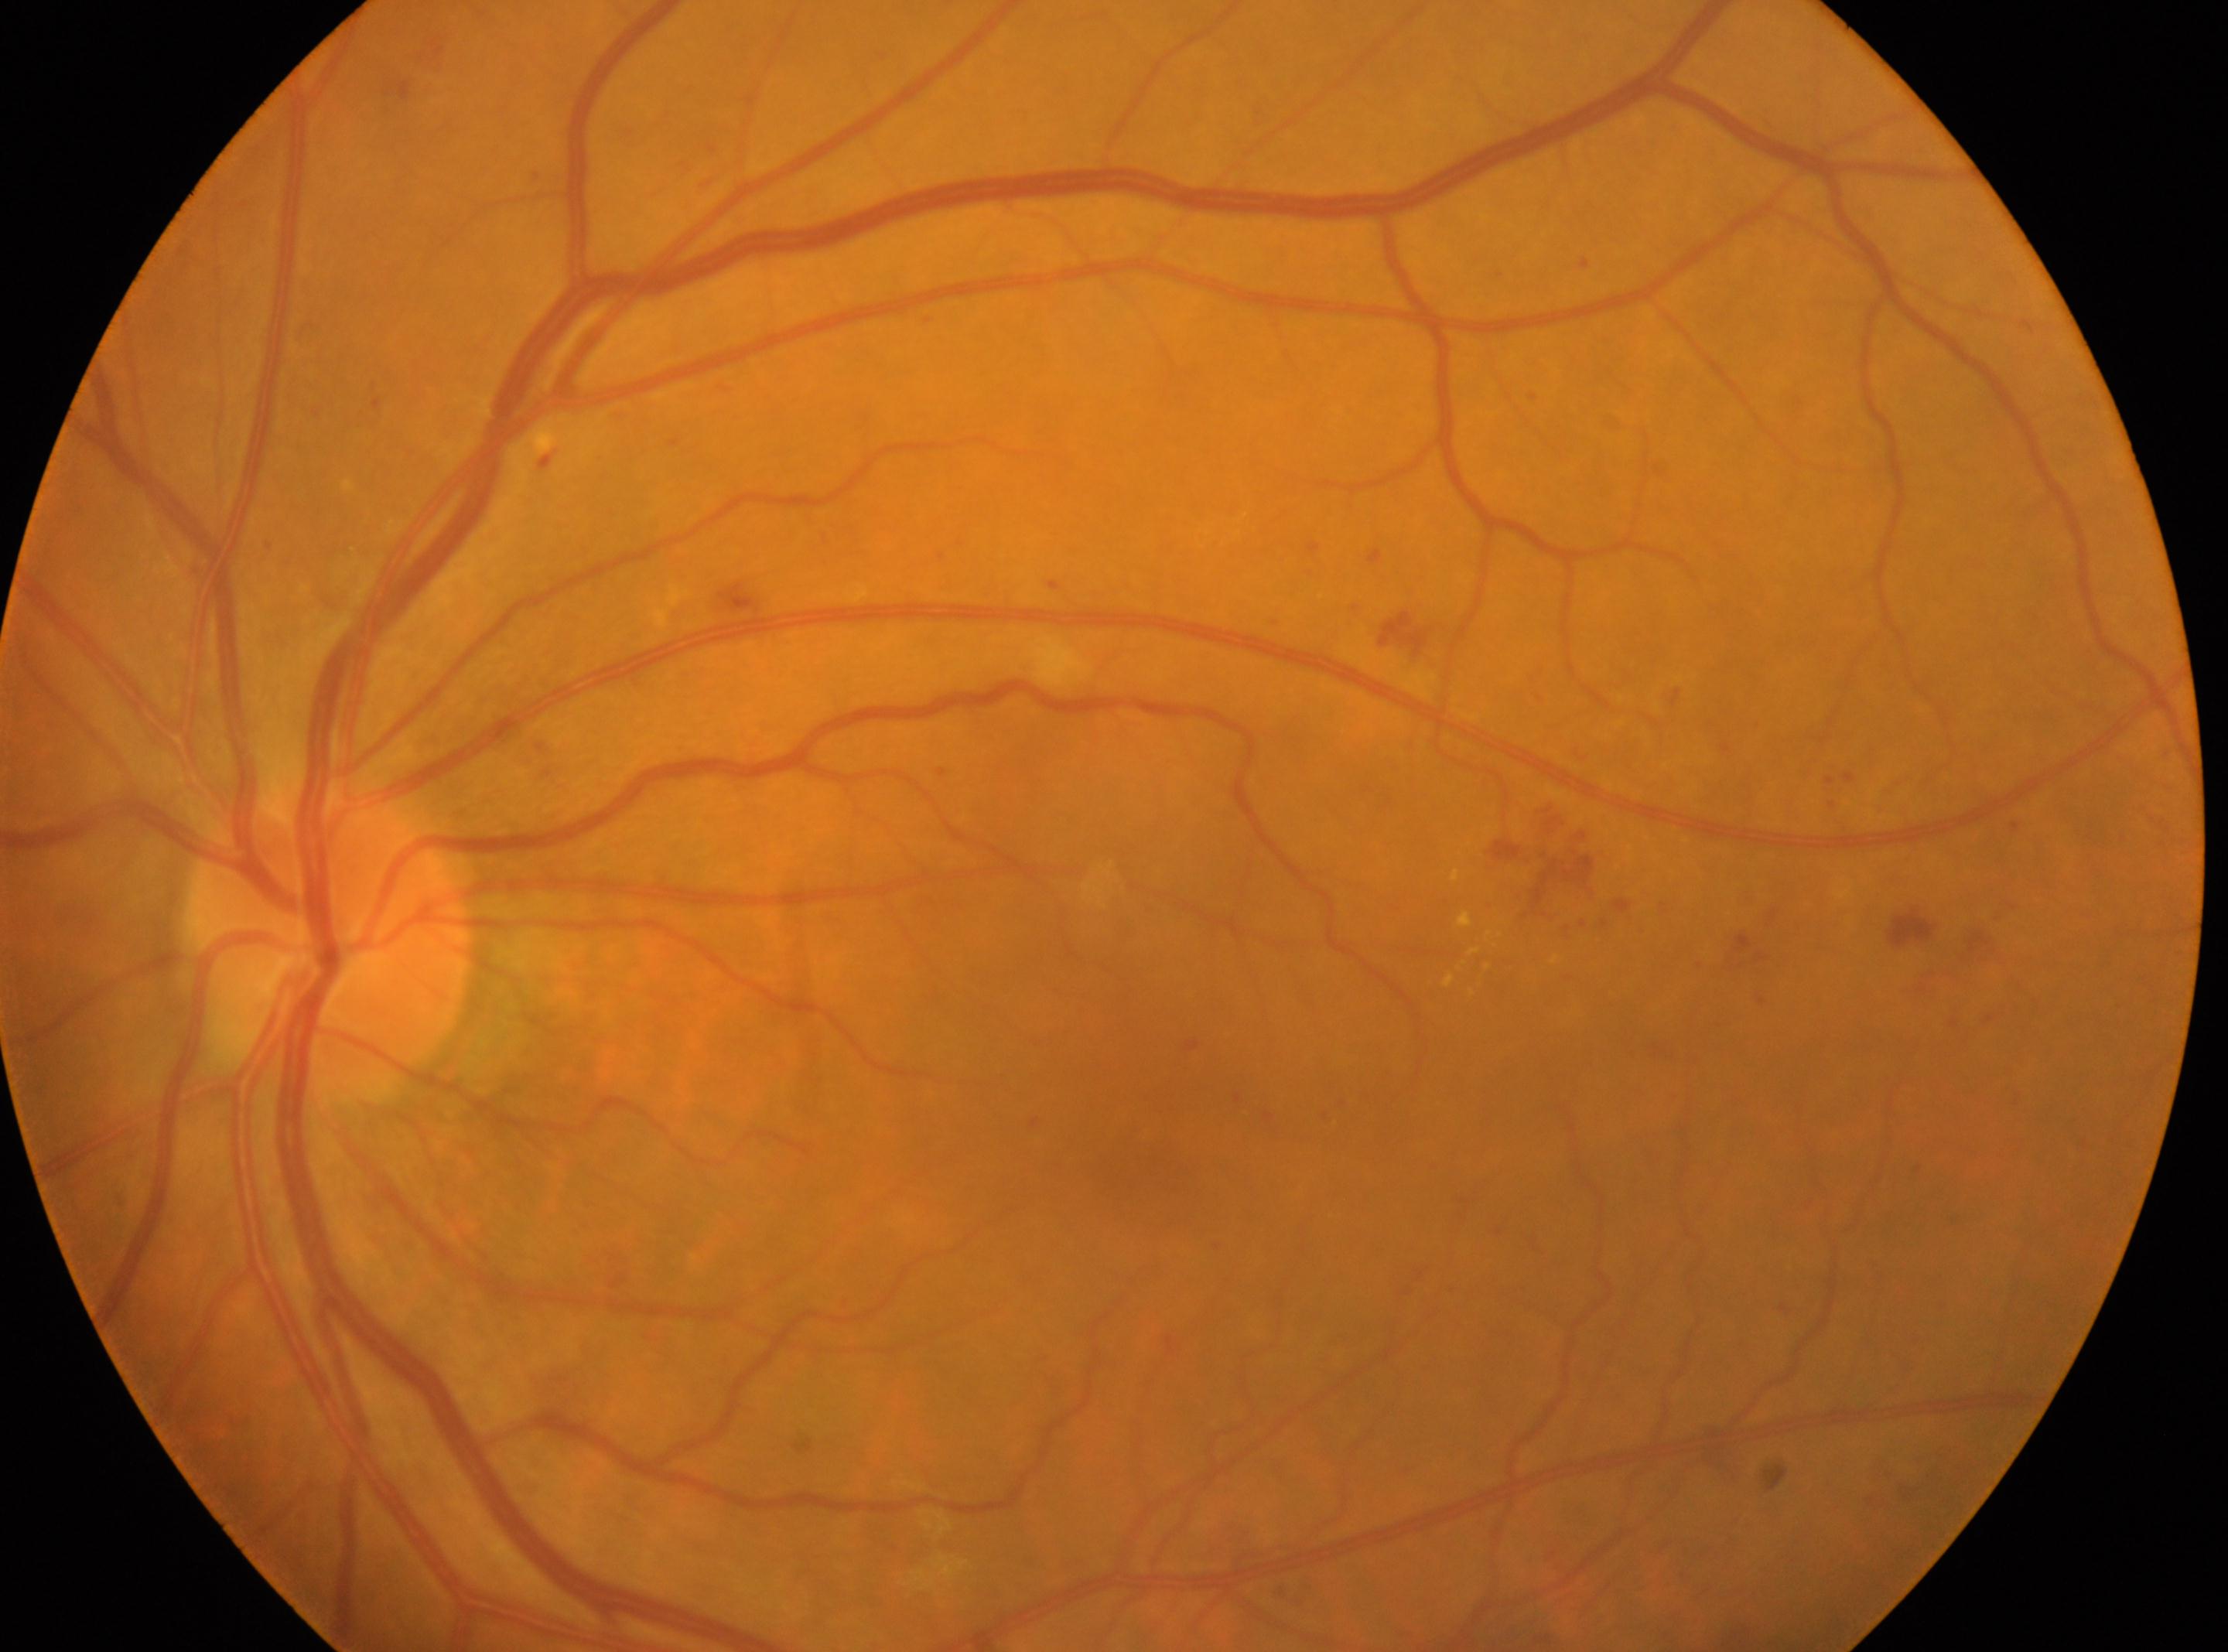
Fovea center located at (x=1137, y=1154). DR: 2. The optic disc is at (x=326, y=940). Eye: left.